Retinal fundus photograph · non-mydriatic acquisition:
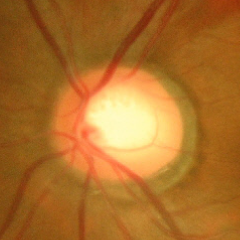

Glaucoma status: advanced glaucoma.